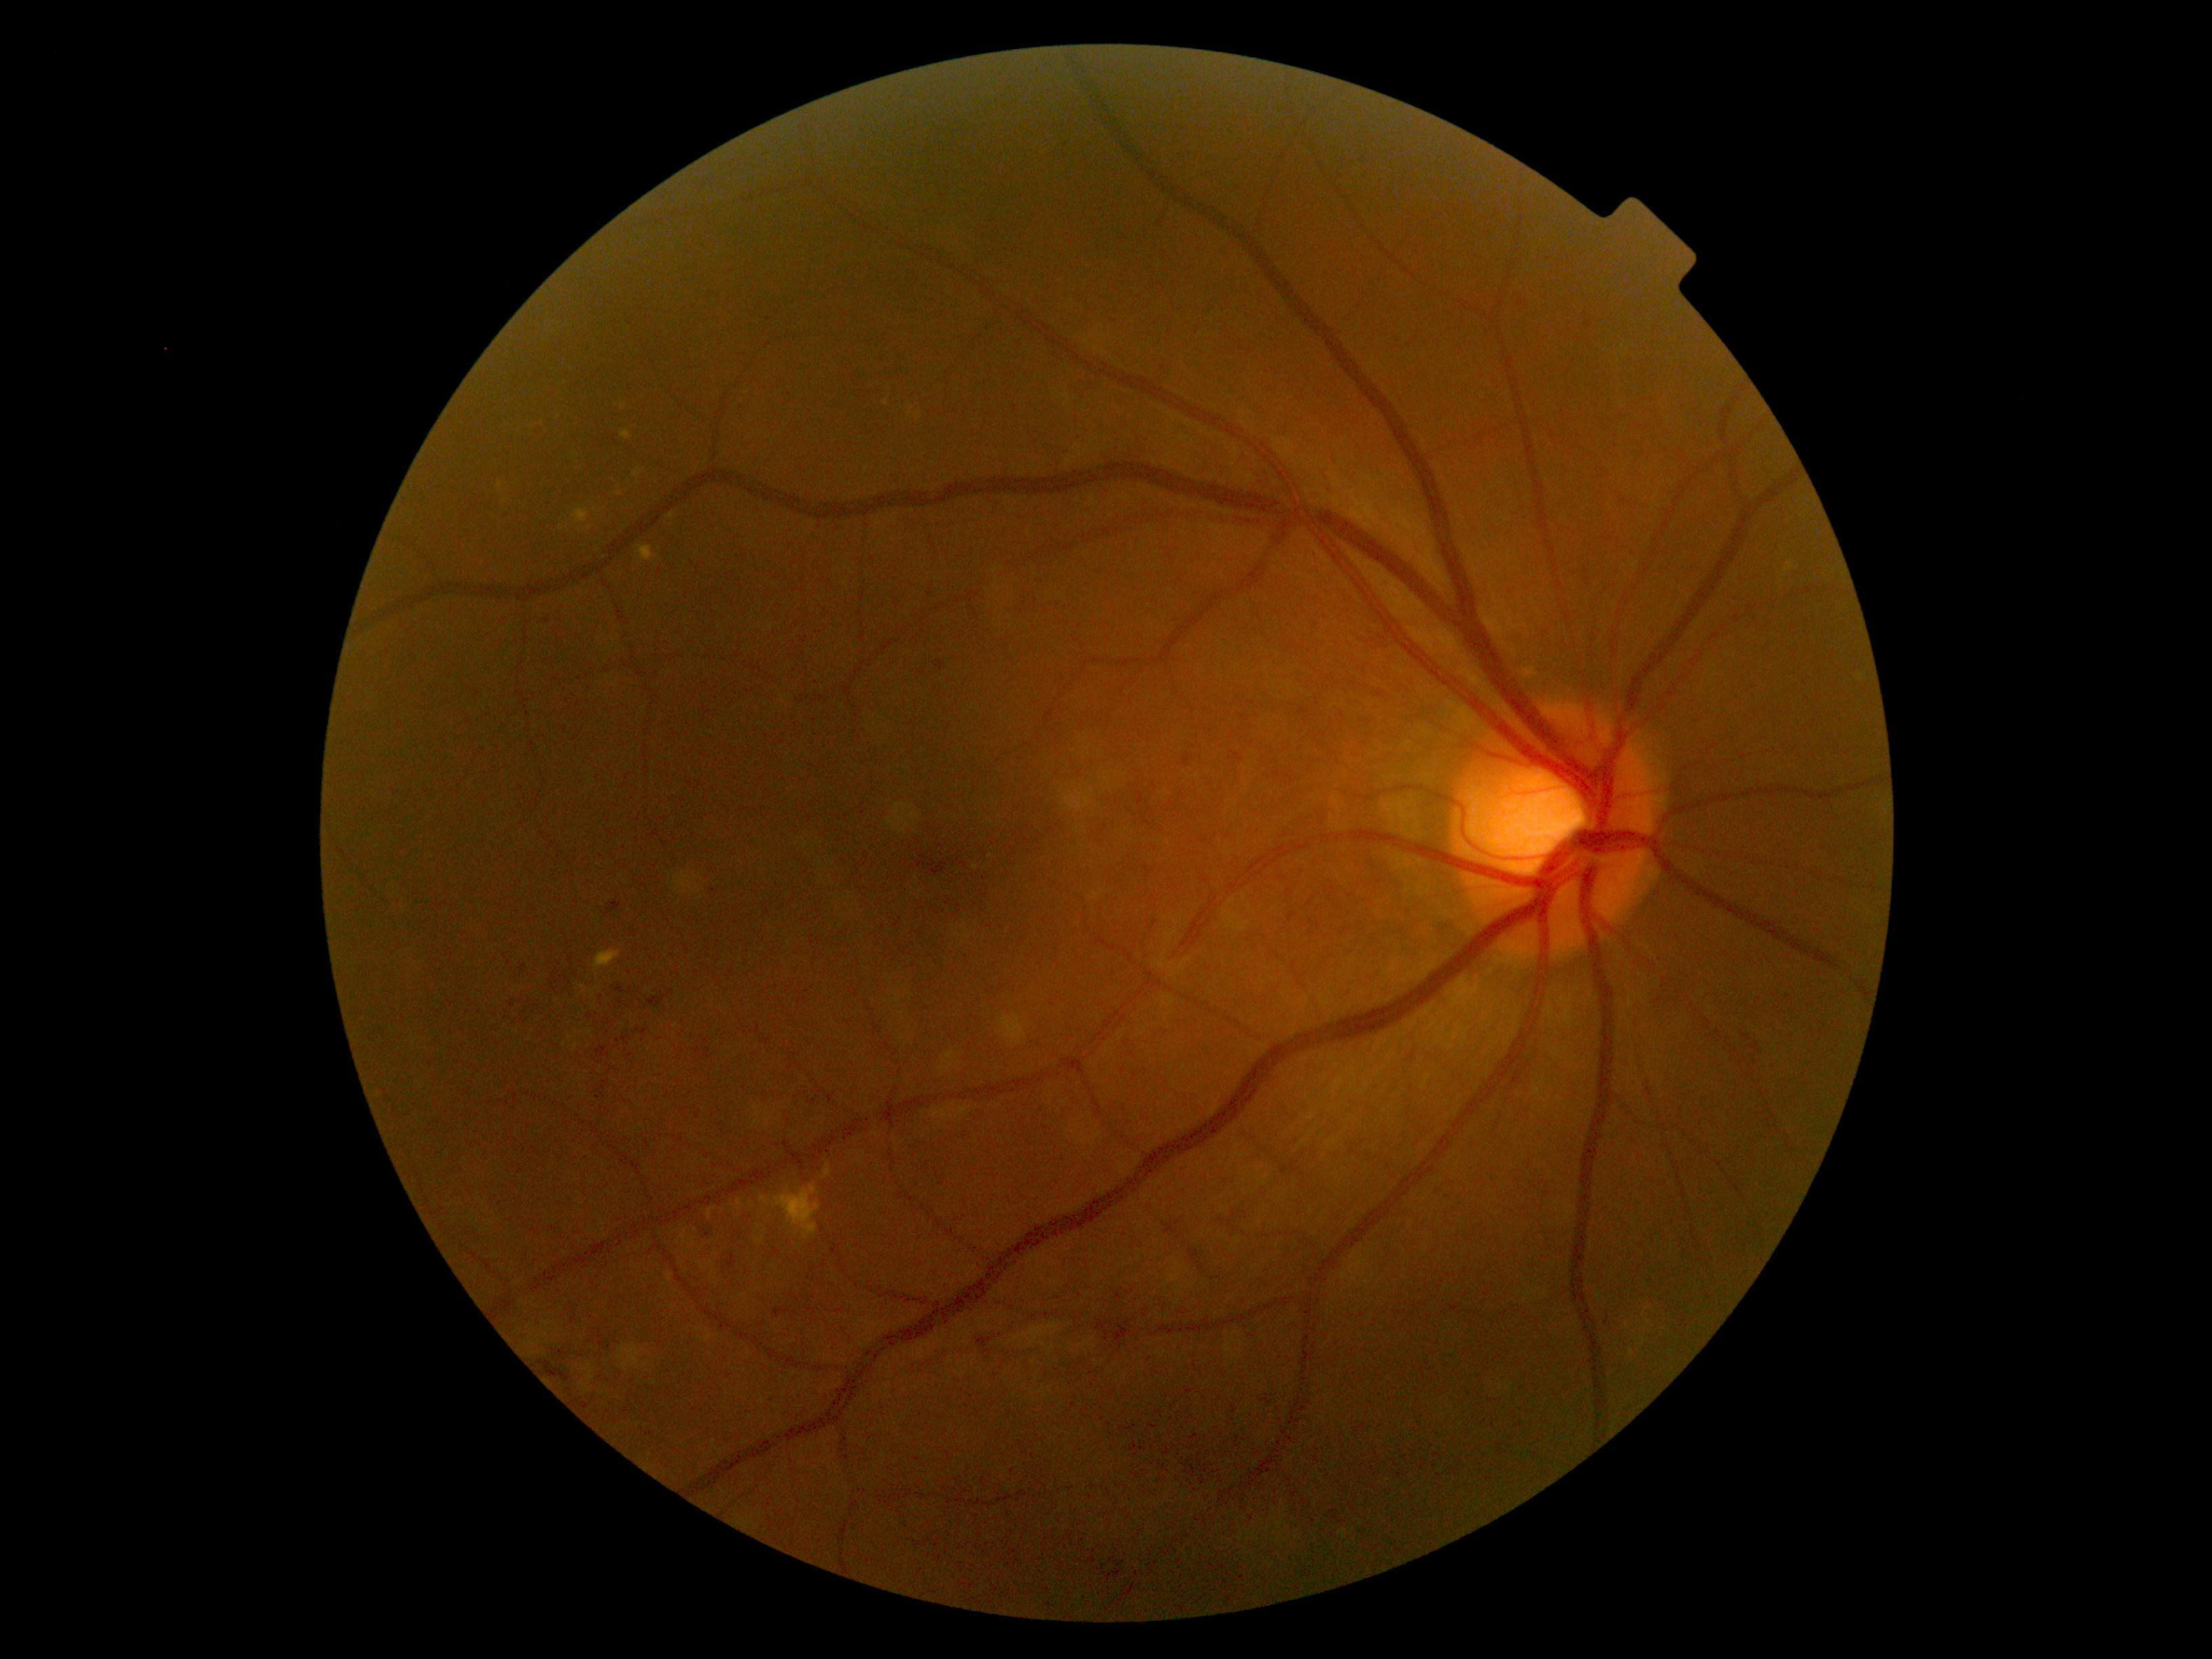 DR severity=2/4, DR class=non-proliferative diabetic retinopathy.